Infant wide-field fundus photograph
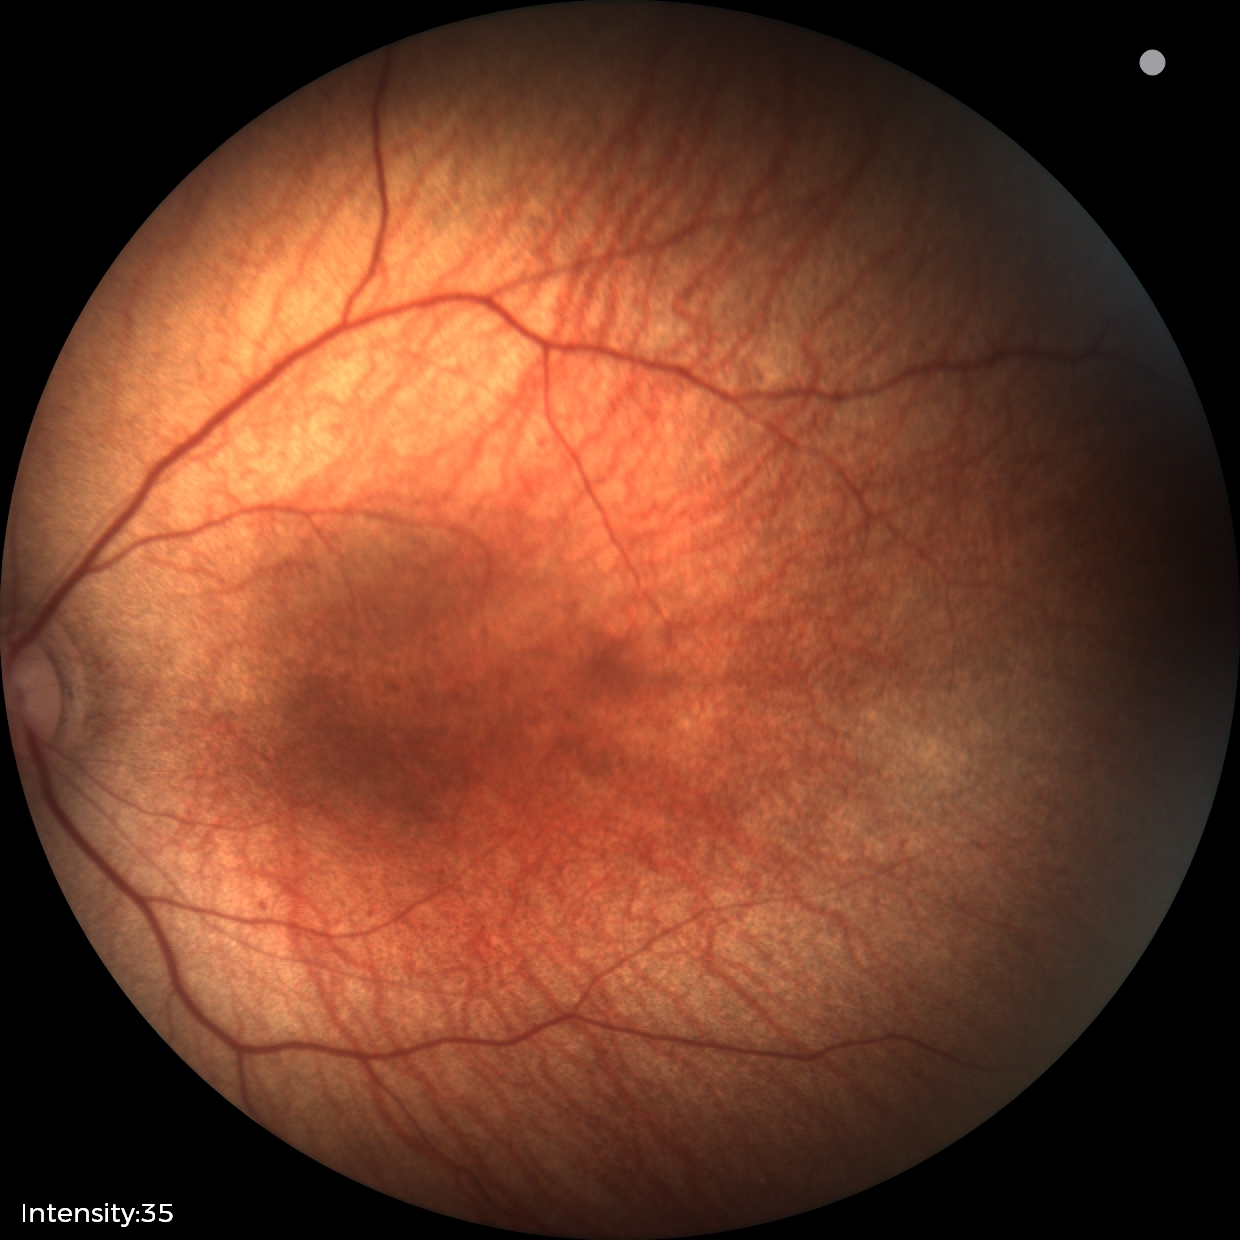 No retinal pathology identified on screening.